Phoenix ICON, 100° FOV · 1240 by 1240 pixels · wide-field contact fundus photograph of an infant: 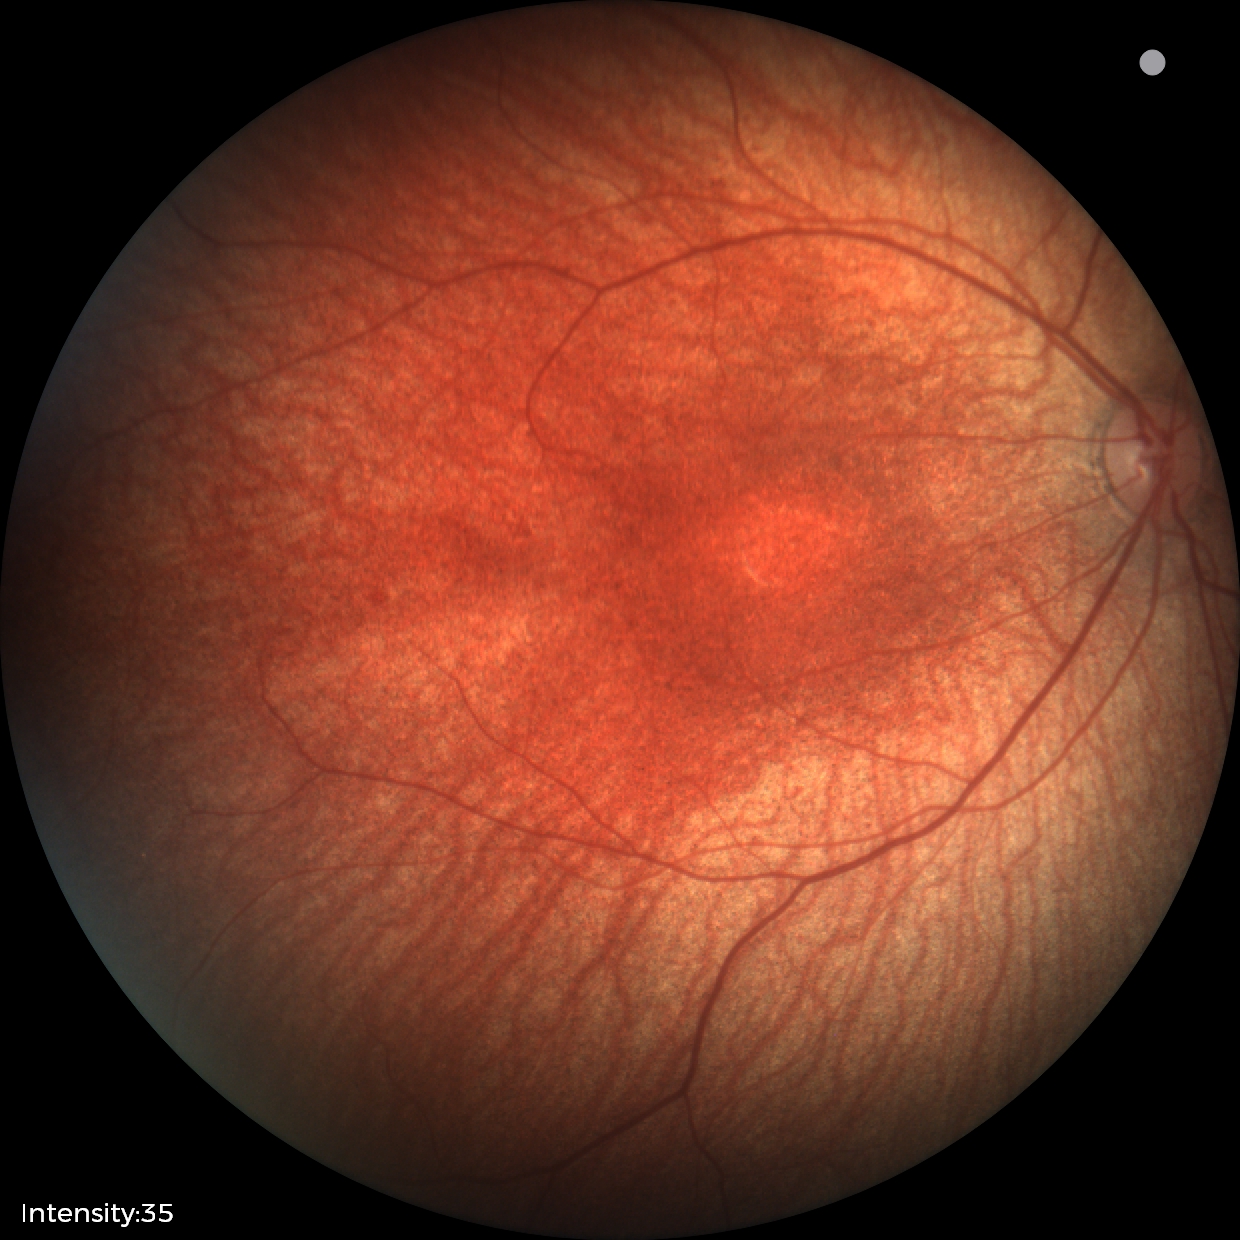
Screening examination with no abnormal retinal findings.